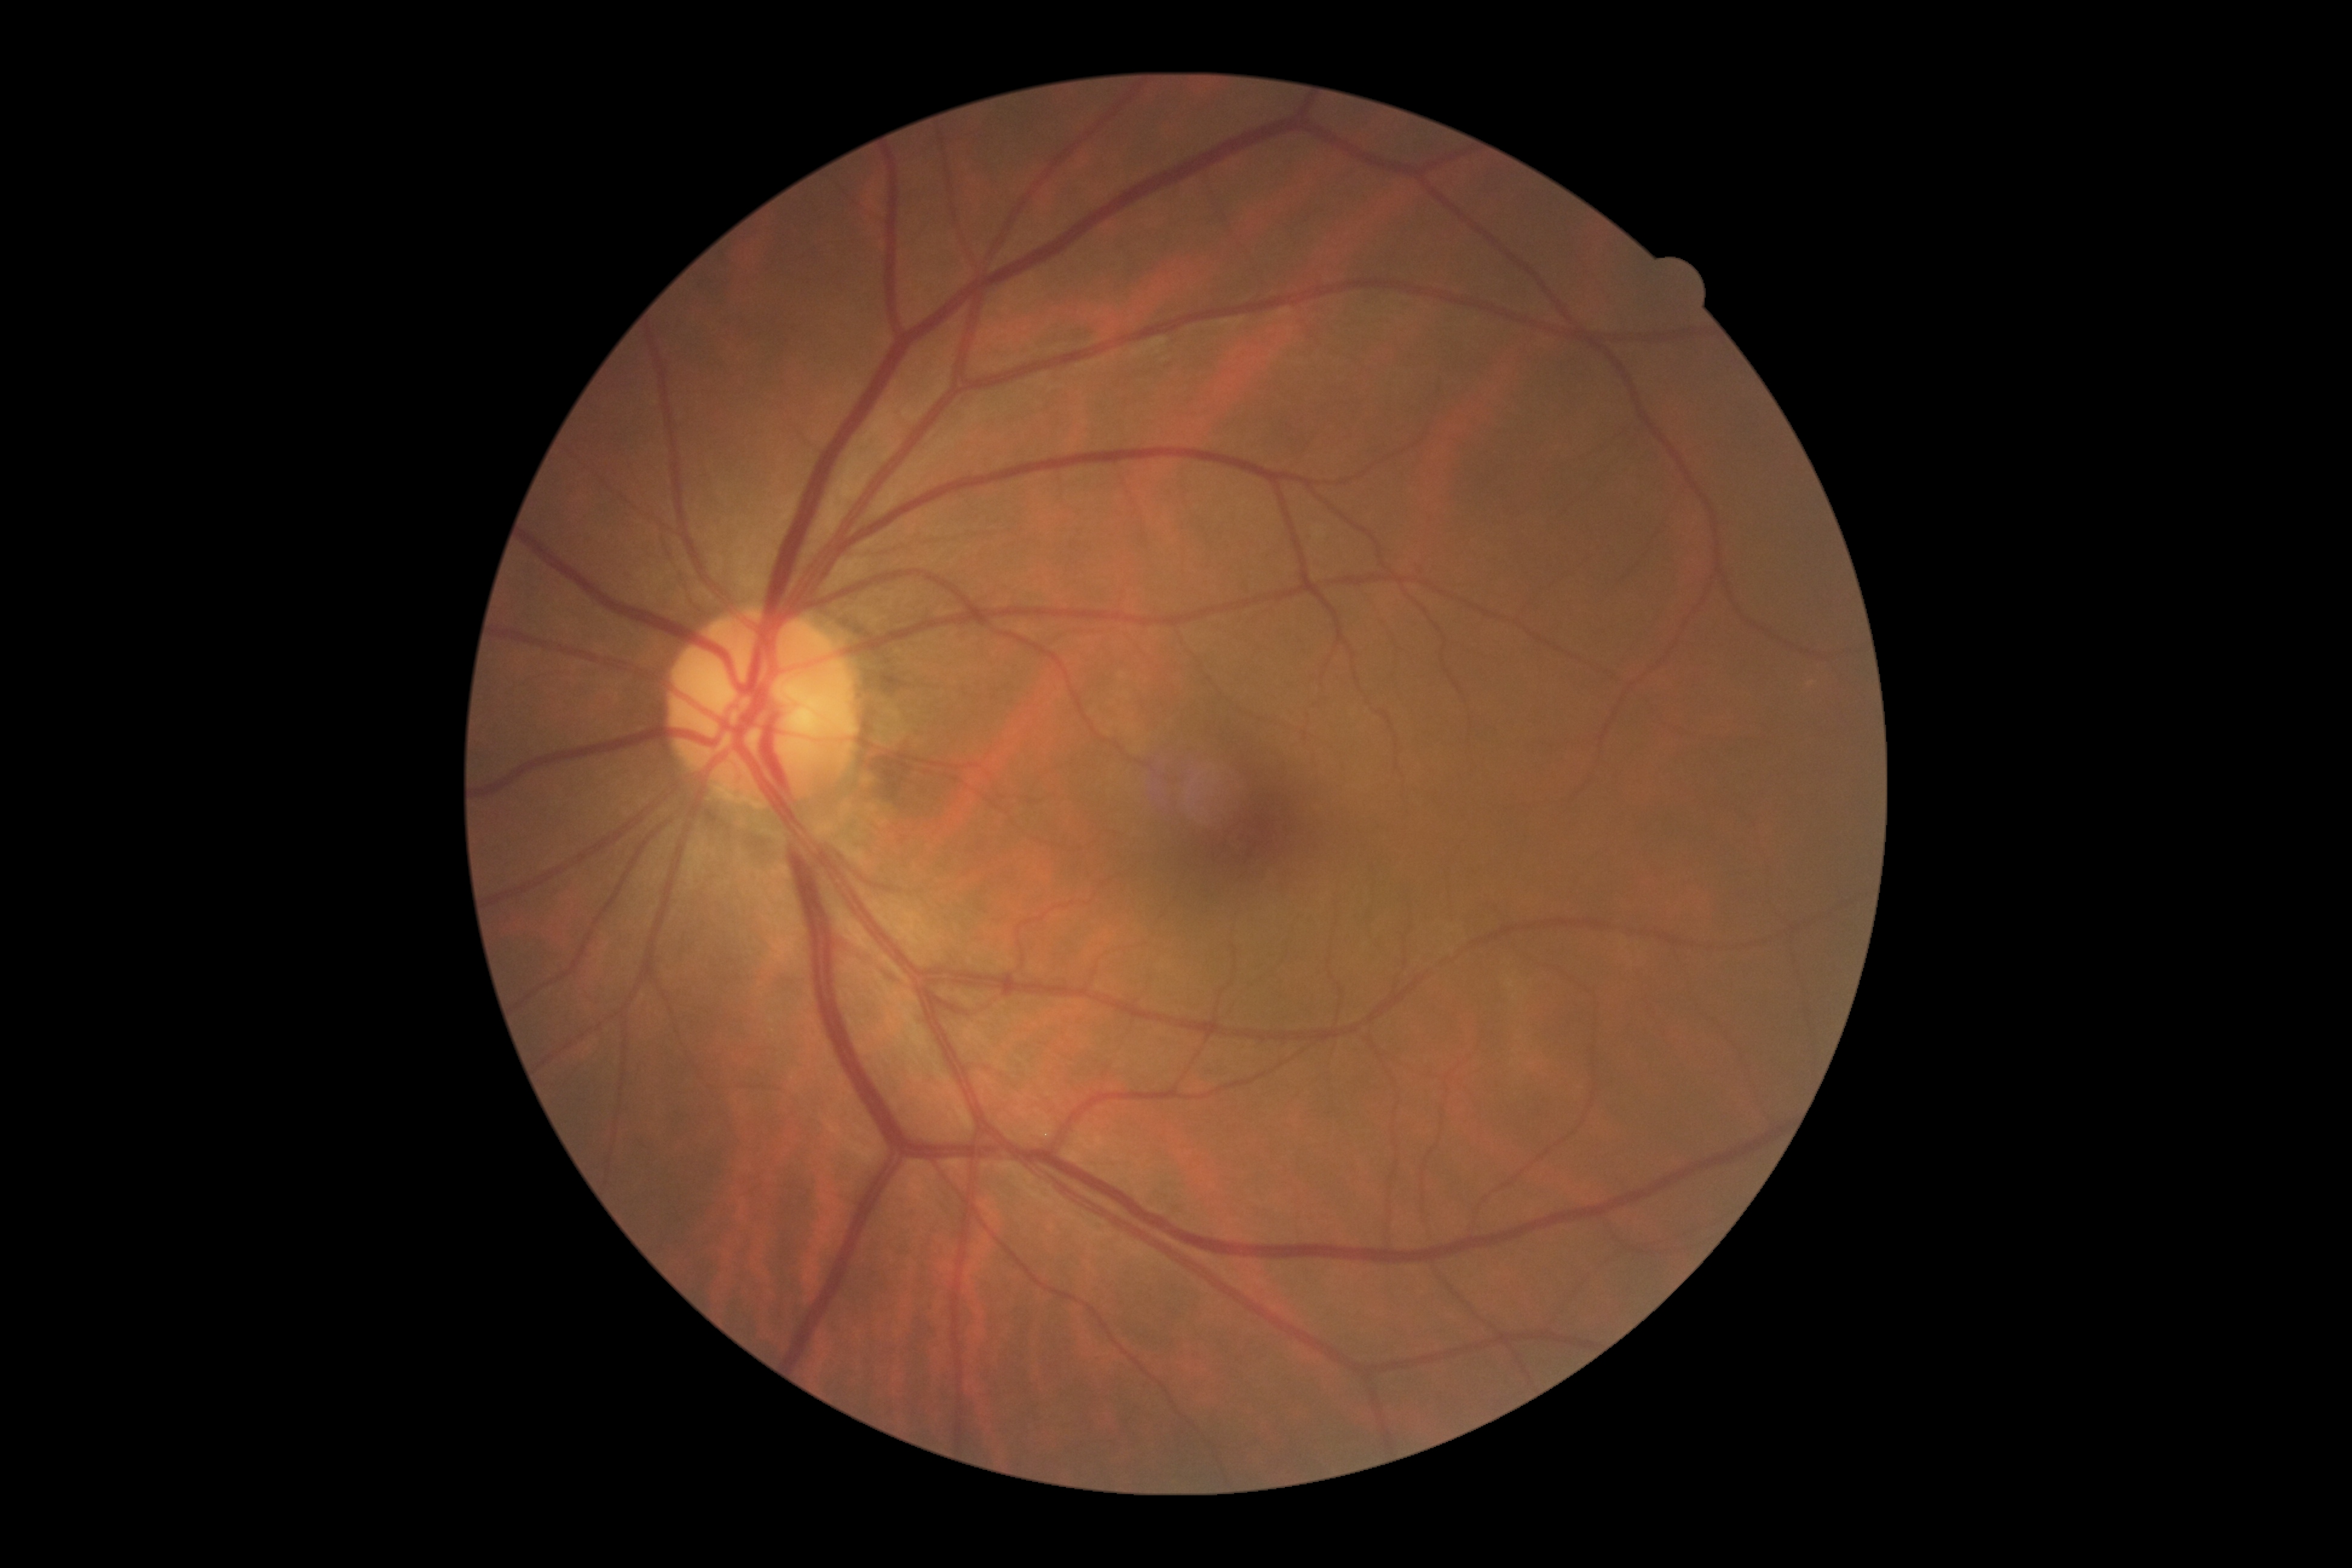

dr_grade: 0